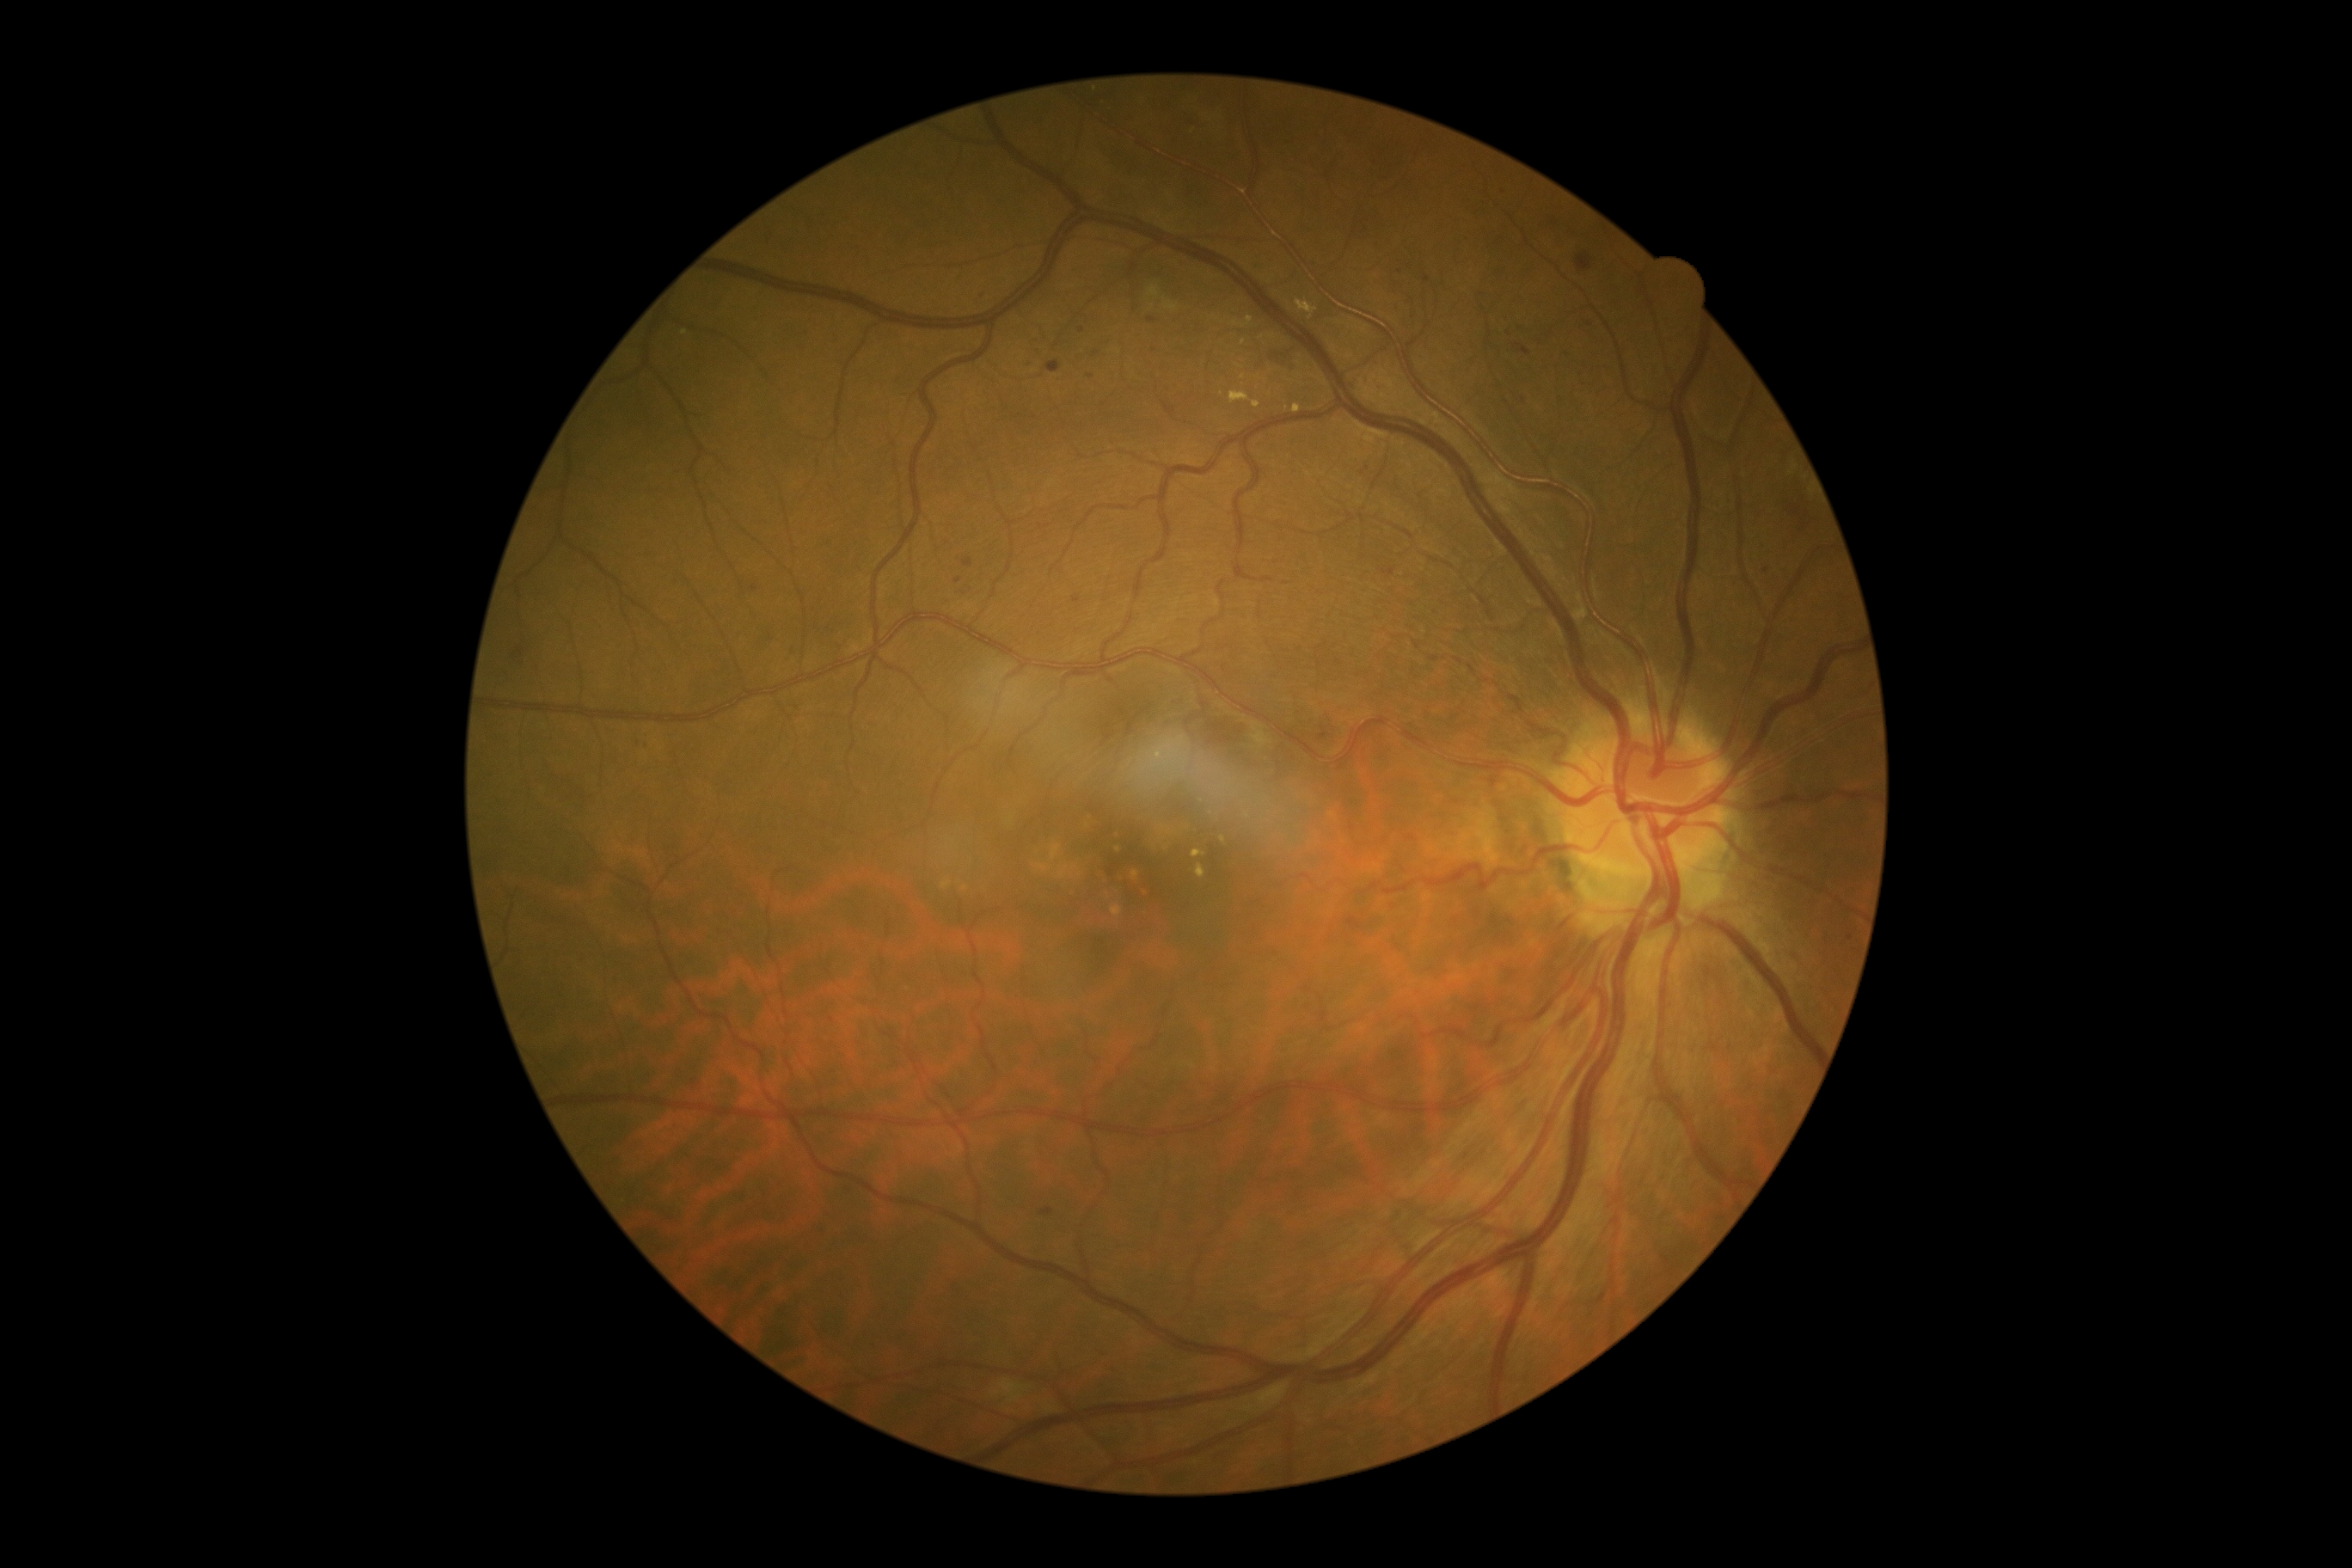
partial: true
dr_grade: 2
lesions:
  ex:
    - {"x1": 1234, "y1": 317, "x2": 1254, "y2": 328}
    - {"x1": 1294, "y1": 405, "x2": 1302, "y2": 413}
    - {"x1": 680, "y1": 331, "x2": 689, "y2": 336}
    - {"x1": 1192, "y1": 850, "x2": 1204, "y2": 859}
    - {"x1": 1253, "y1": 401, "x2": 1261, "y2": 408}
    - {"x1": 1228, "y1": 391, "x2": 1251, "y2": 405}
    - {"x1": 1196, "y1": 866, "x2": 1206, "y2": 879}
    - {"x1": 1295, "y1": 300, "x2": 1318, "y2": 321}
  ex_small:
    - 1223, 840
    - 1244, 343
    - 1243, 378
  he:
    - {"x1": 1576, "y1": 252, "x2": 1595, "y2": 273}
    - {"x1": 511, "y1": 647, "x2": 525, "y2": 661}
    - {"x1": 1270, "y1": 350, "x2": 1297, "y2": 369}
    - {"x1": 1785, "y1": 505, "x2": 1811, "y2": 534}
  ma:
    - {"x1": 1074, "y1": 596, "x2": 1082, "y2": 603}
    - {"x1": 1383, "y1": 568, "x2": 1395, "y2": 577}
    - {"x1": 1361, "y1": 469, "x2": 1369, "y2": 475}
    - {"x1": 1046, "y1": 362, "x2": 1060, "y2": 374}
    - {"x1": 1318, "y1": 726, "x2": 1330, "y2": 742}
  ma_small:
    - 1765, 570
    - 1524, 401
    - 1427, 279
    - 1569, 353
    - 1096, 354
    - 851, 1190
    - 648, 747
    - 958, 581
  se:
    - {"x1": 991, "y1": 1380, "x2": 1024, "y2": 1406}
    - {"x1": 1253, "y1": 723, "x2": 1270, "y2": 749}
    - {"x1": 1046, "y1": 1407, "x2": 1055, "y2": 1414}
    - {"x1": 1163, "y1": 756, "x2": 1168, "y2": 764}